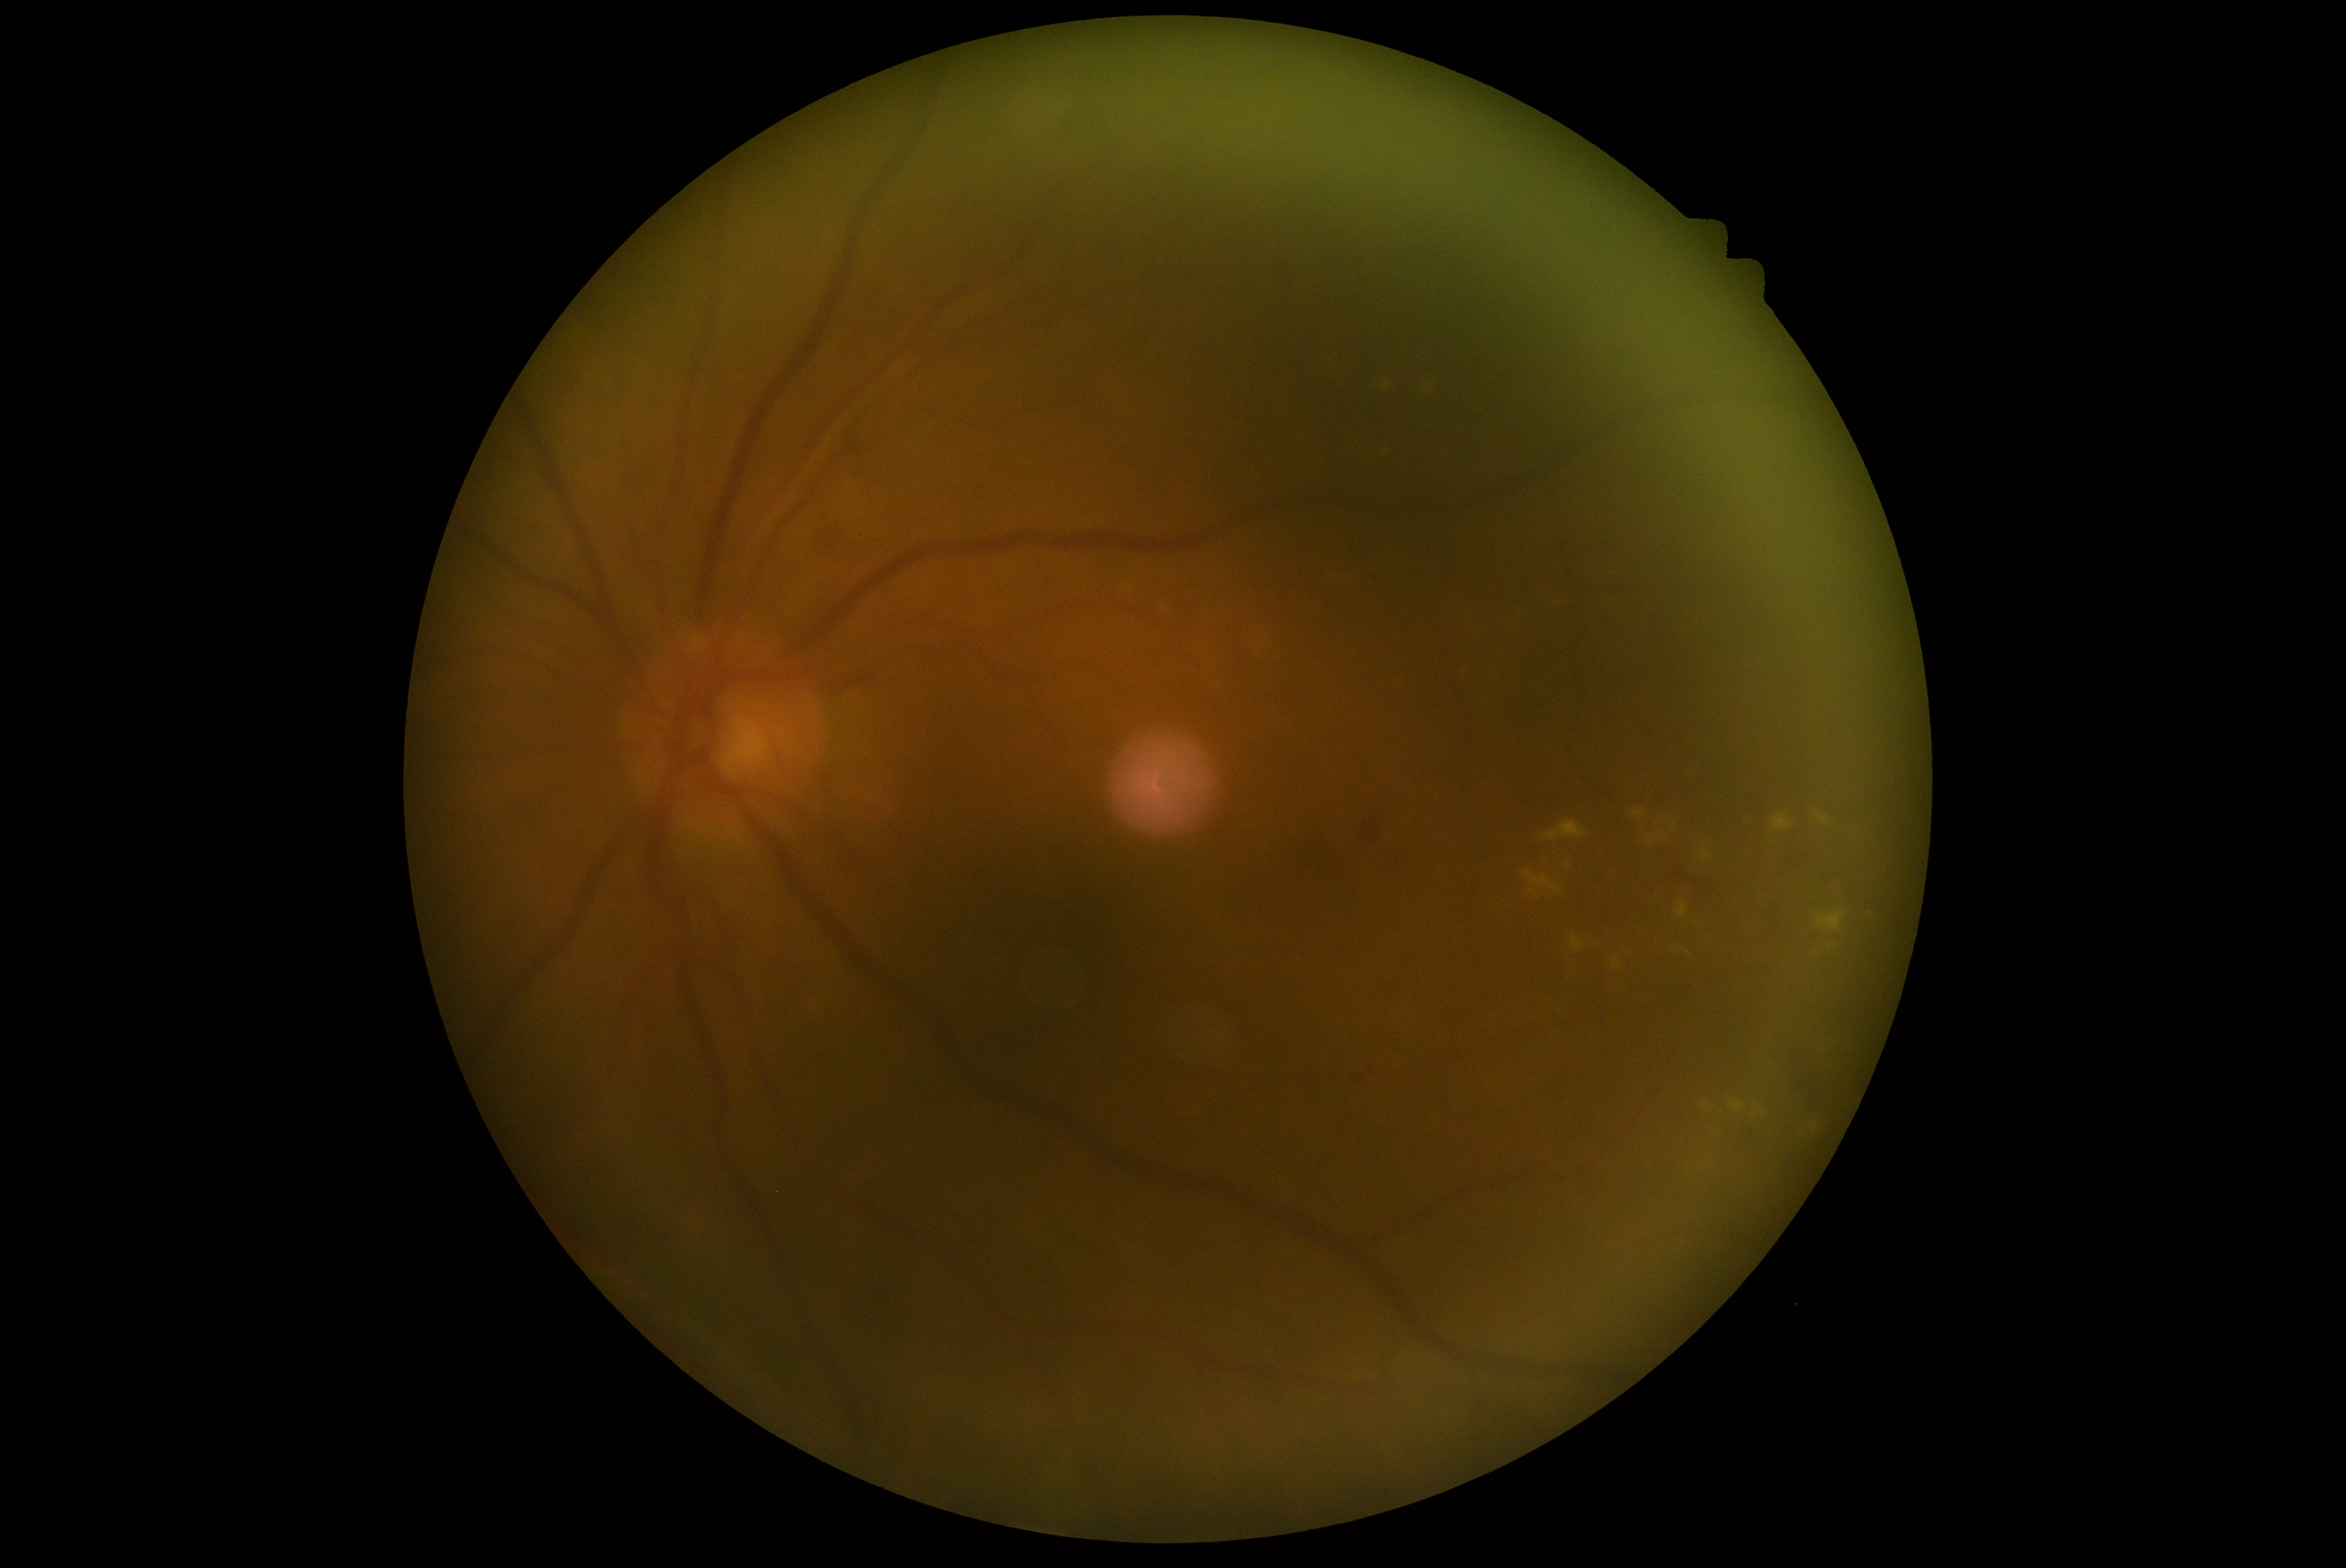
DR severity is moderate NPDR (grade 2). The retinopathy is classified as non-proliferative diabetic retinopathy.